60-degree field of view · 2212 x 1659 pixels · fundus photo taken with a portable handheld camera: 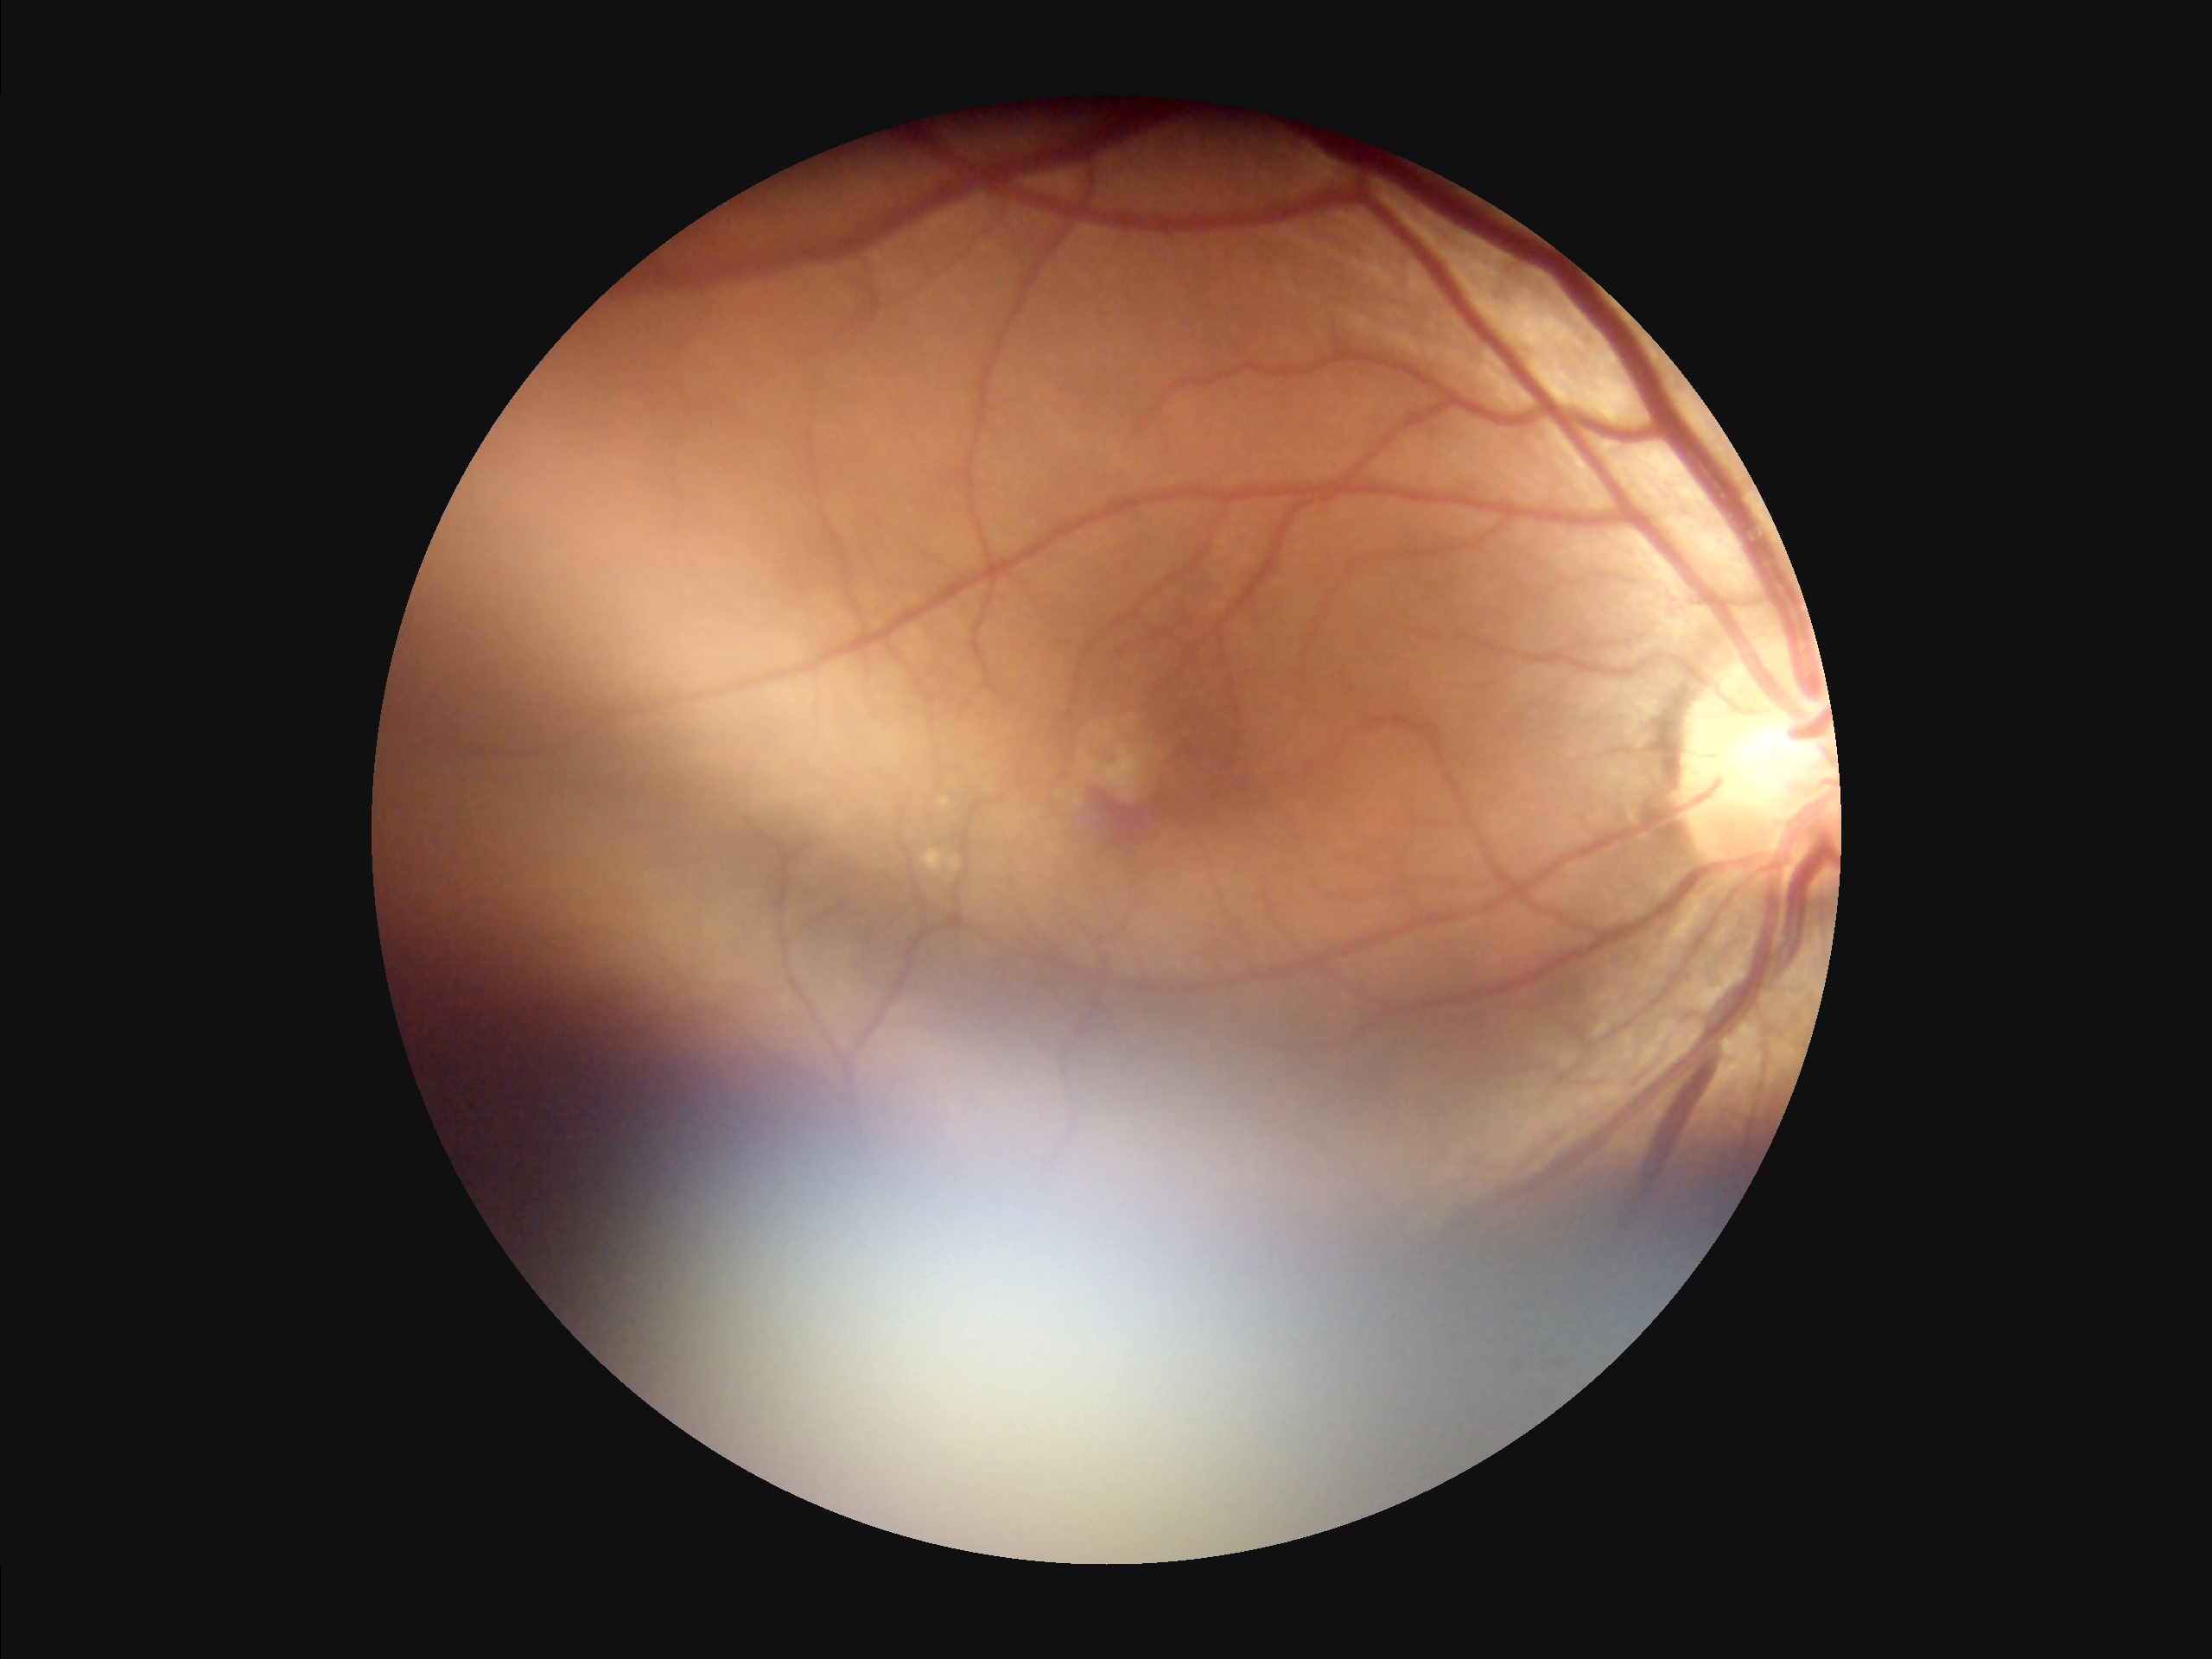

Illumination and color are suboptimal. Reduced sharpness with visible blur. Overall image quality is poor. Good dynamic range.